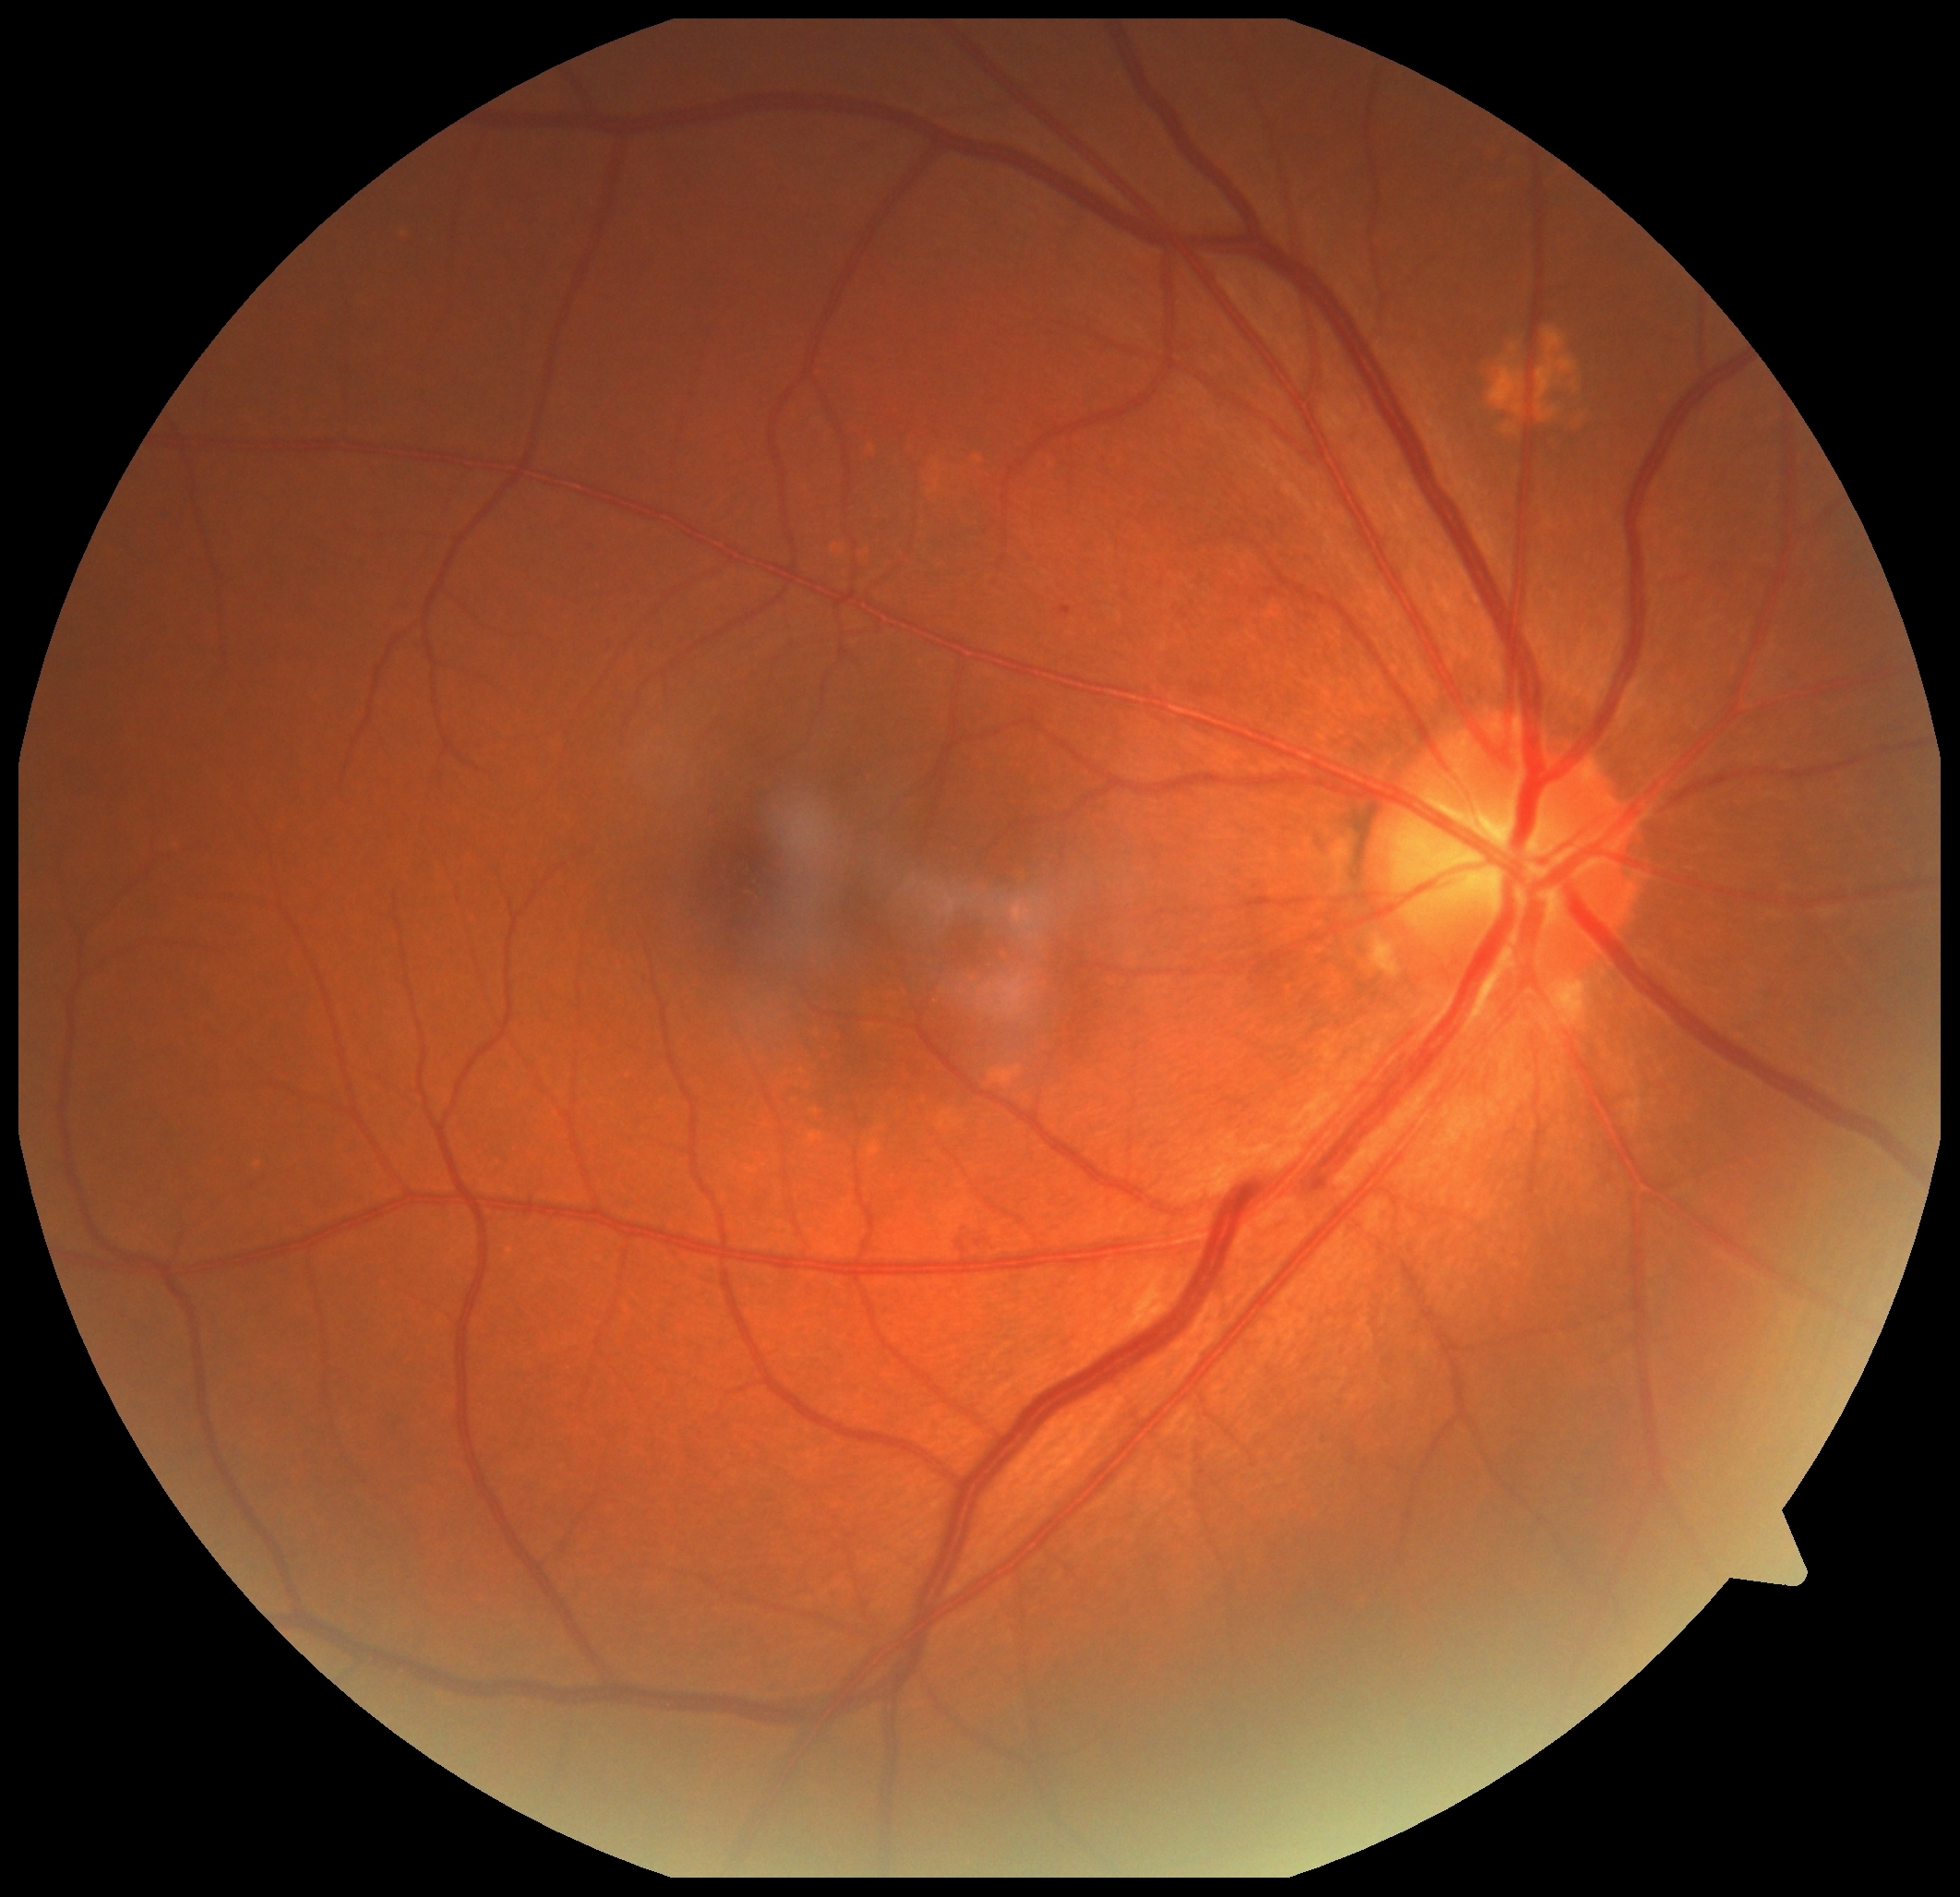 DR grade: 2.